Captured after pupil dilation. 2228 x 1652 pixels
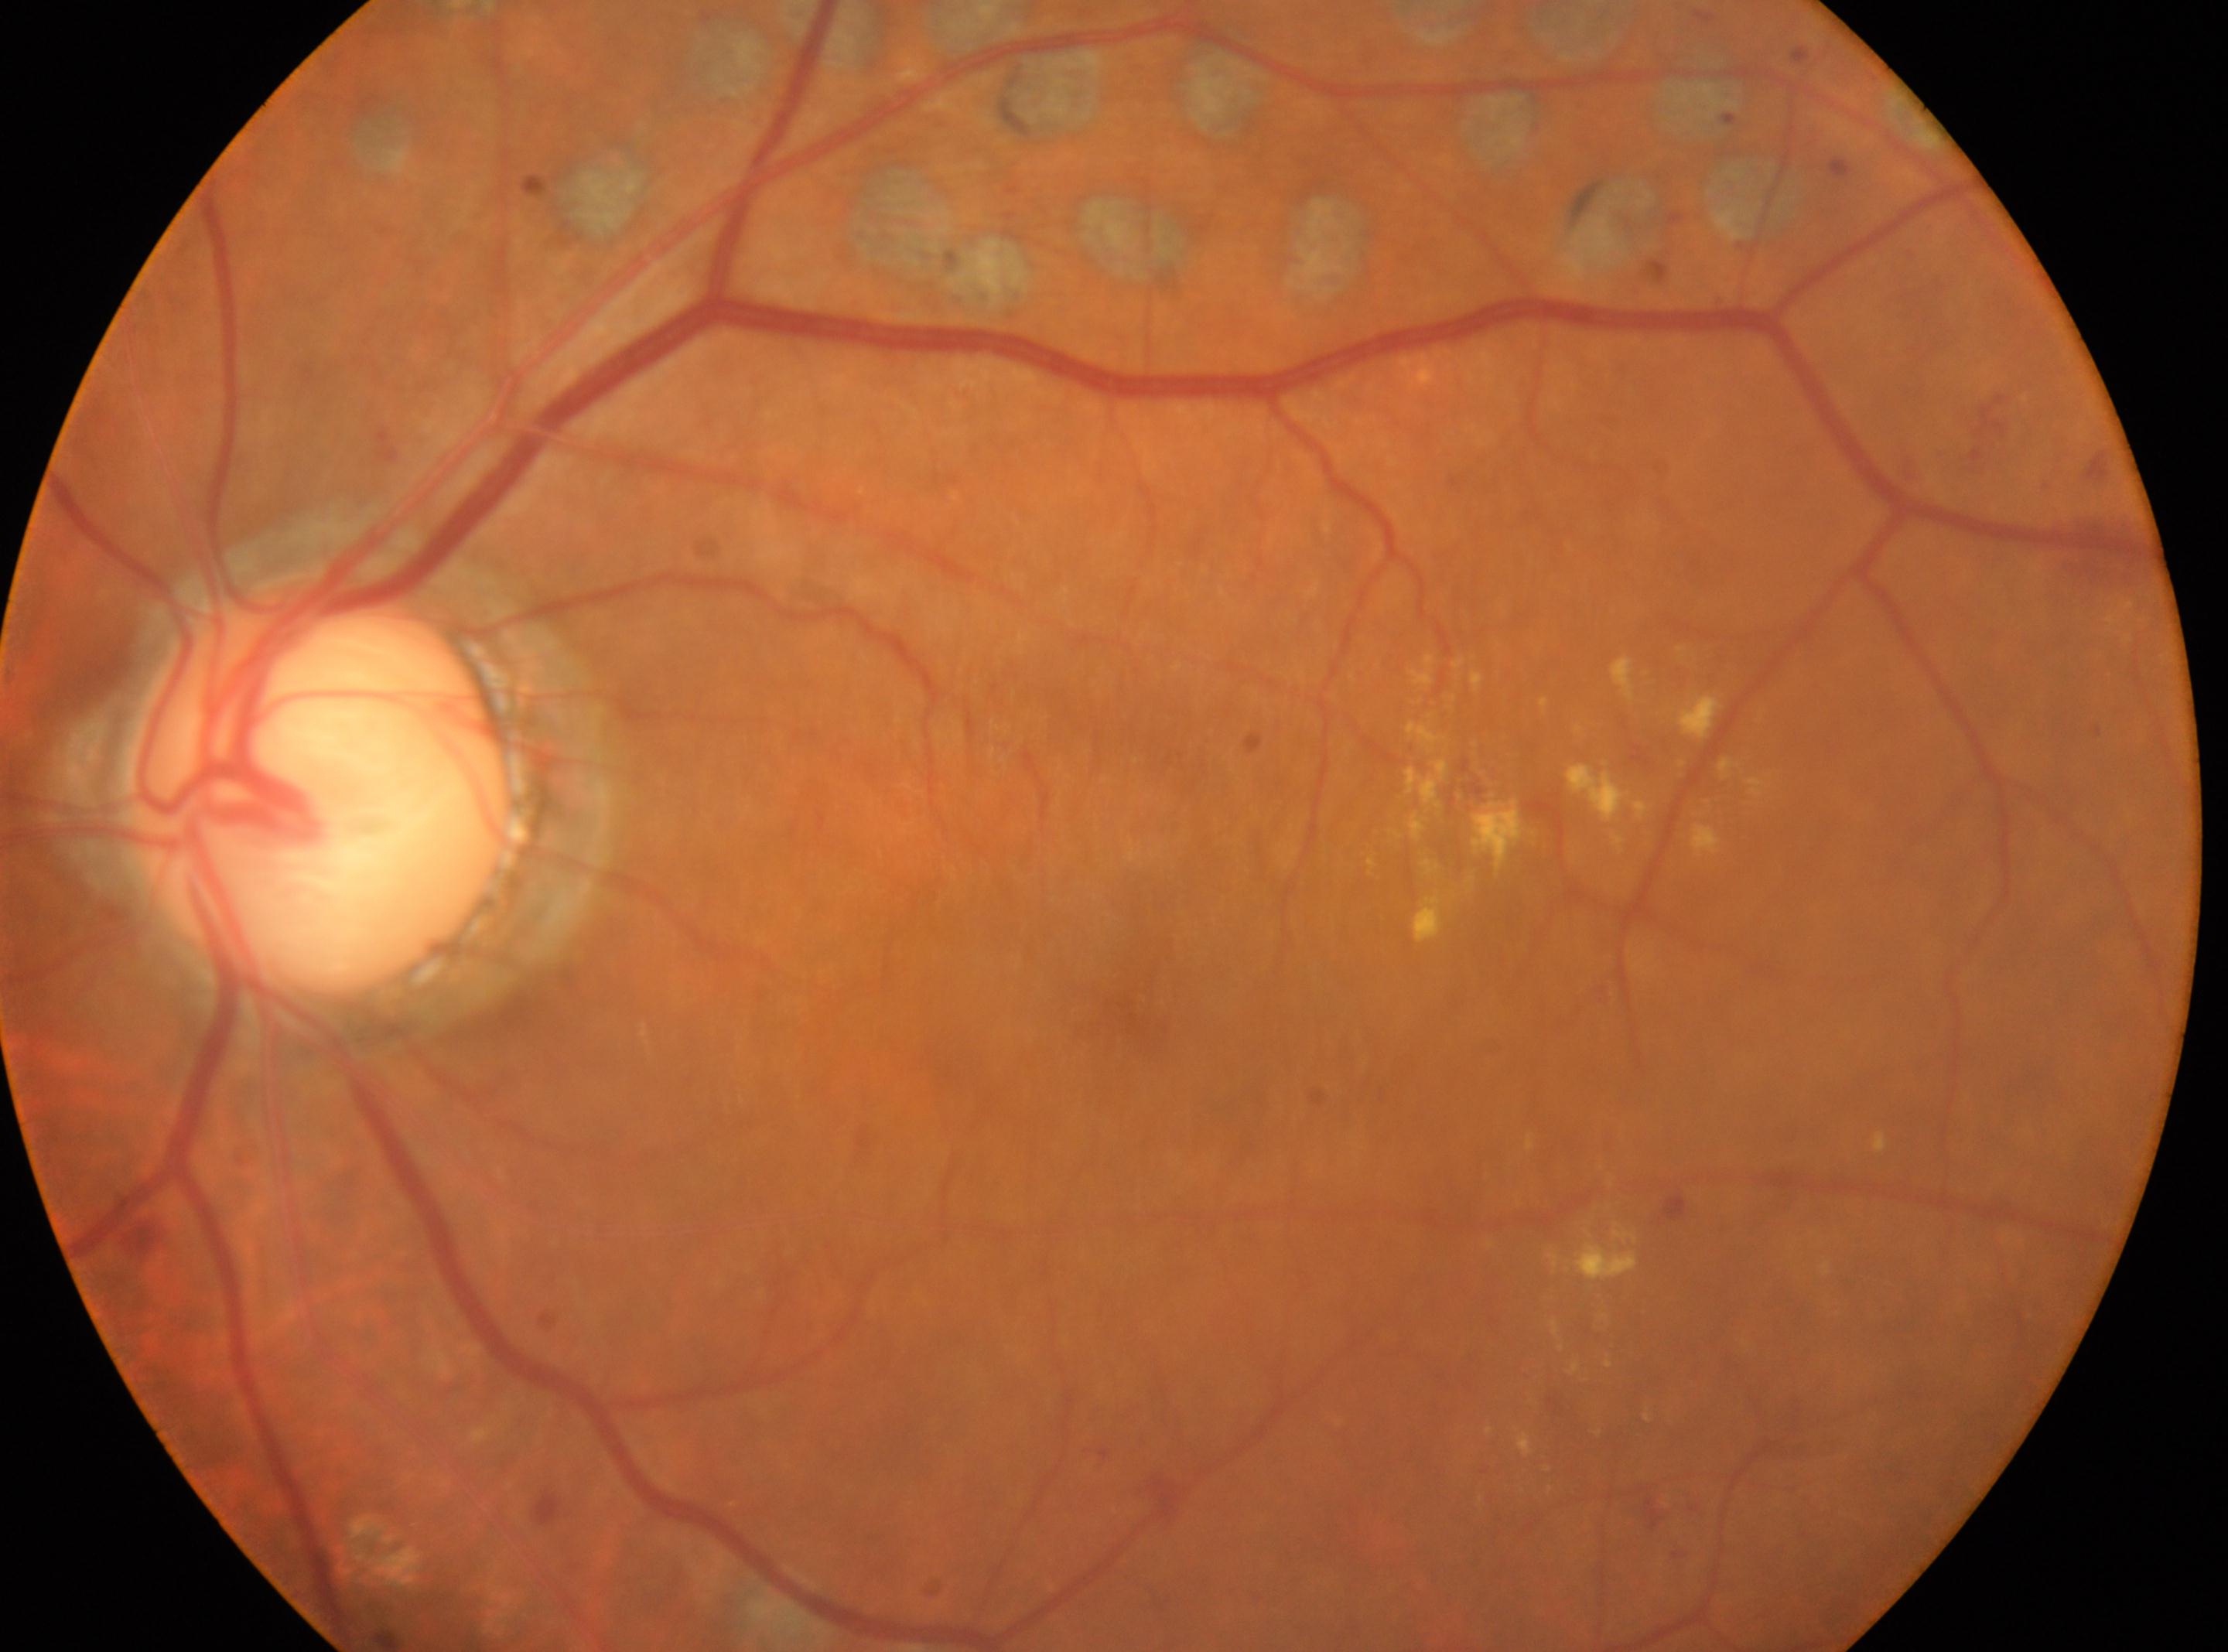 The fovea is at (1143, 1016).
DR stage: laser-treated DR — evidence of prior retinal laser photocoagulation (laser spots or scars).
Imaged eye: left eye.
The ONH is at (319, 788).